2102 x 1736 pixels:
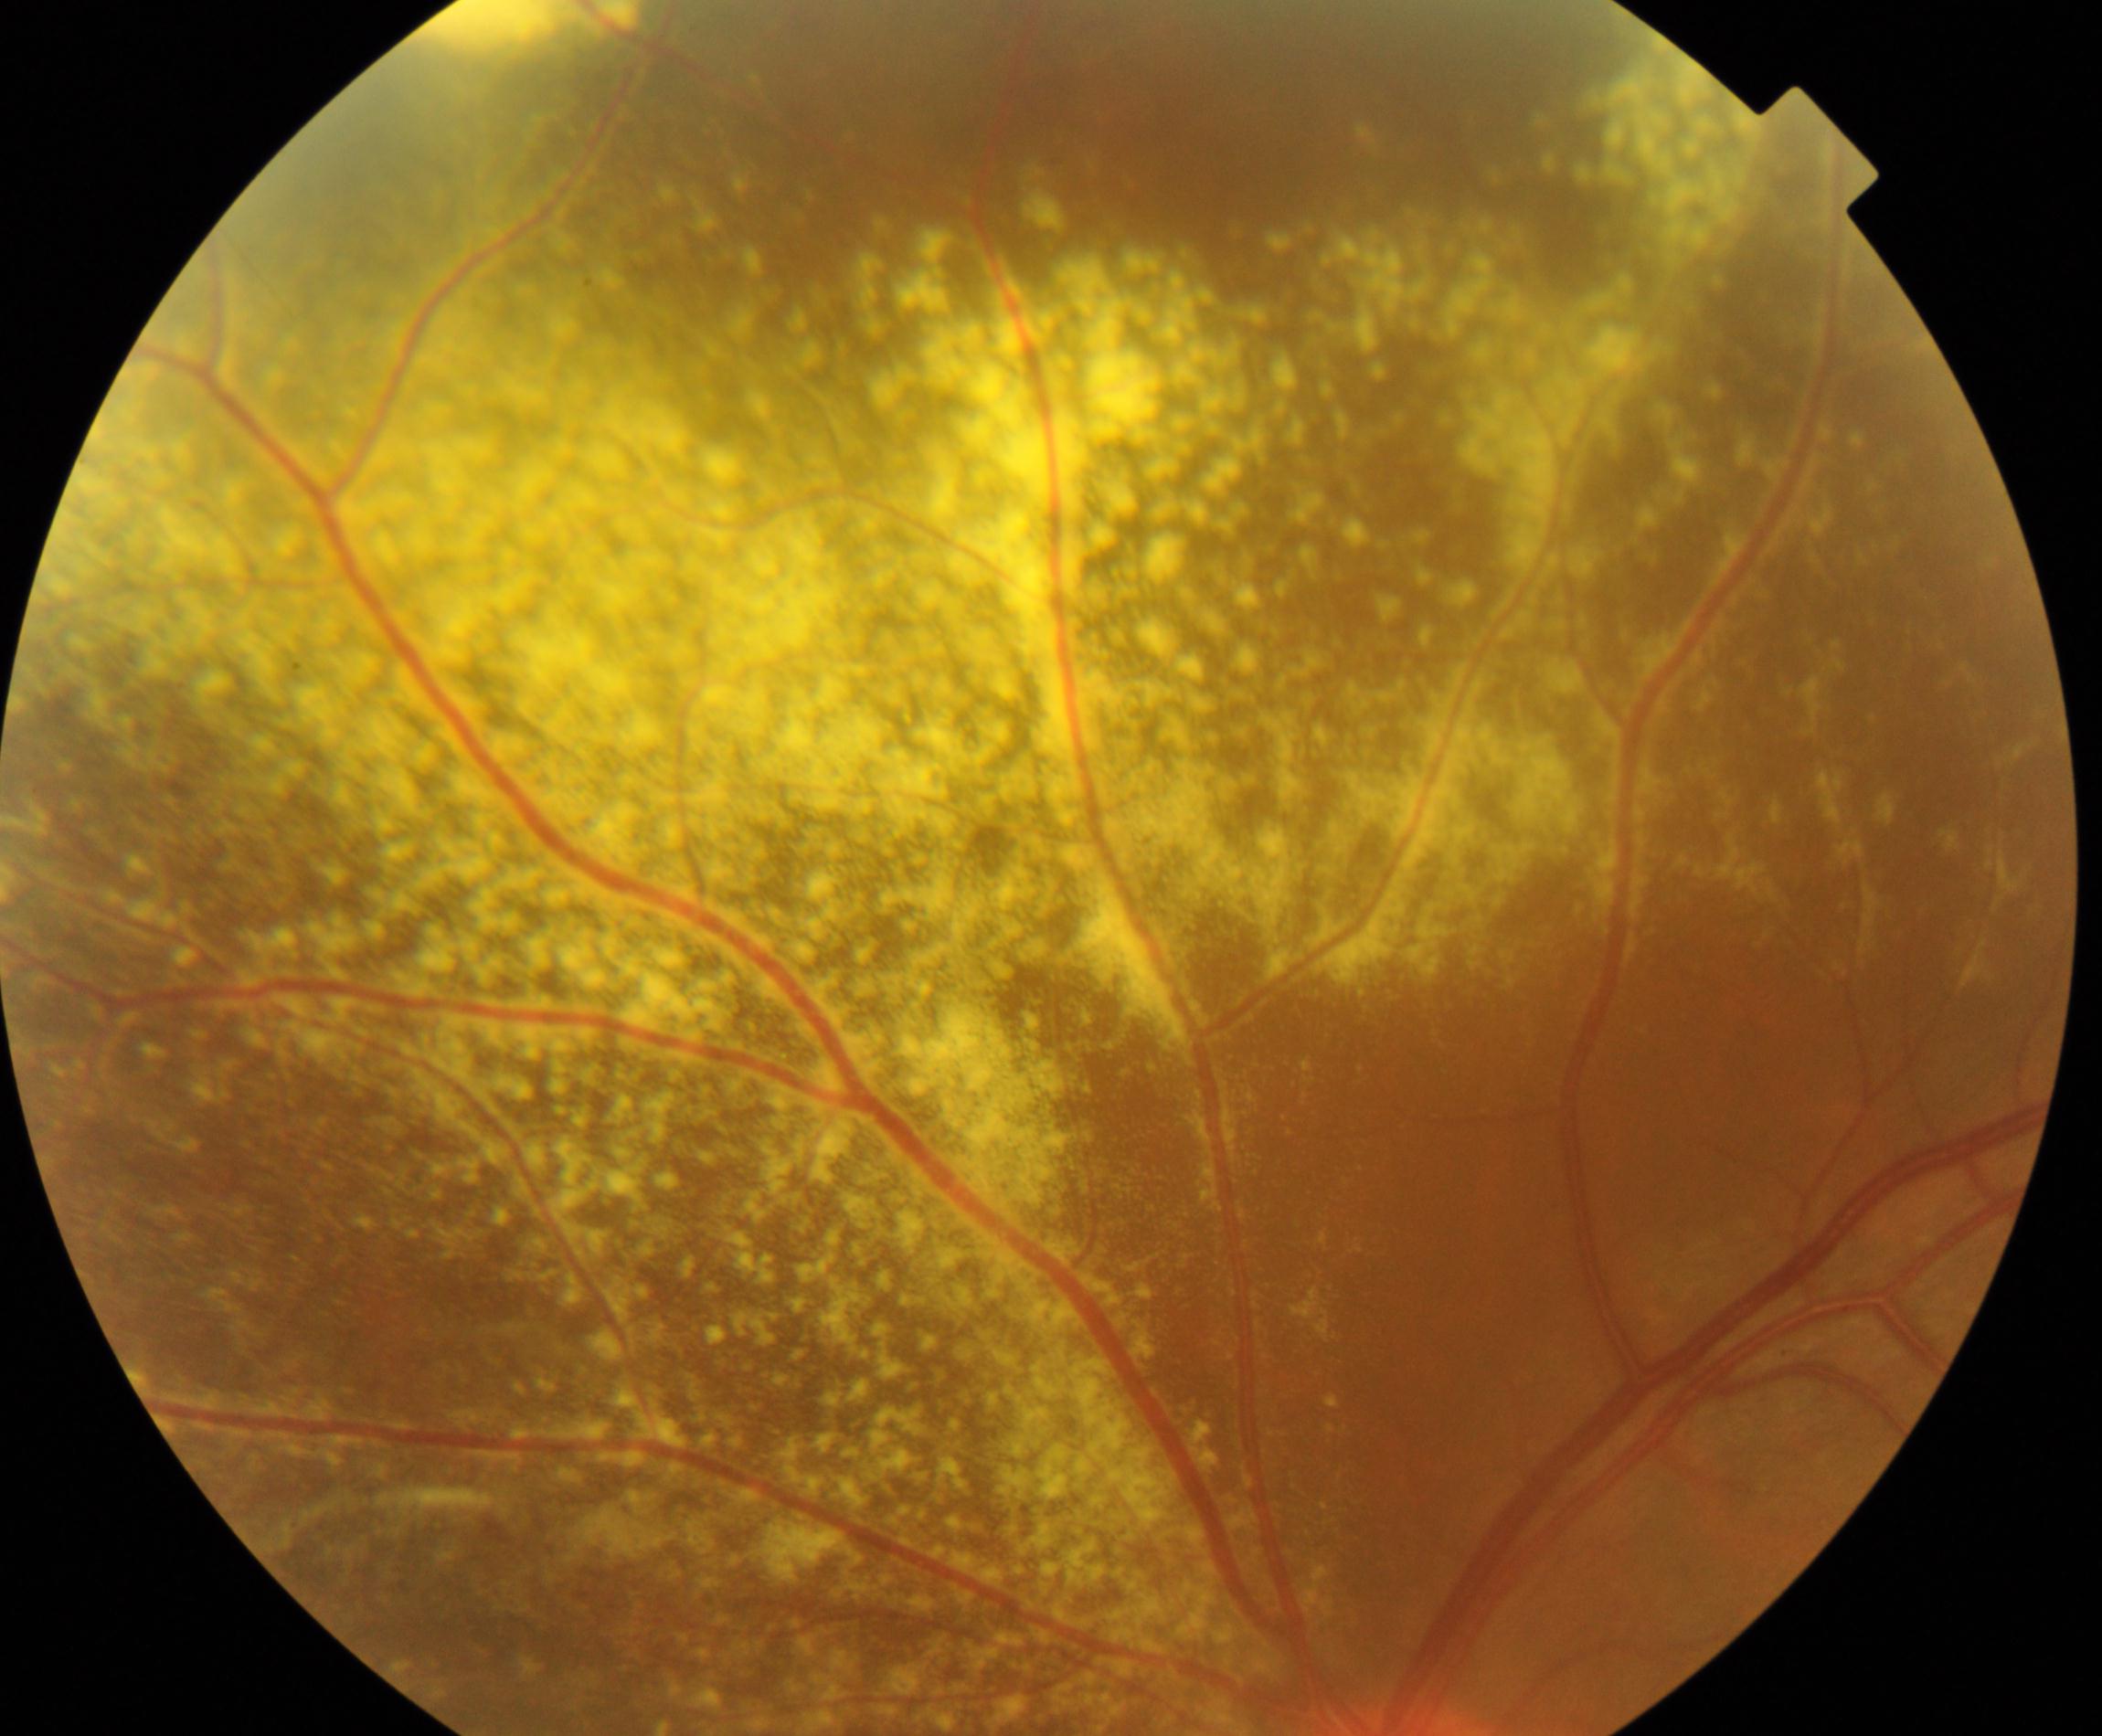
Fundus image consistent with massive hard exudates.